2212 by 1659 pixels
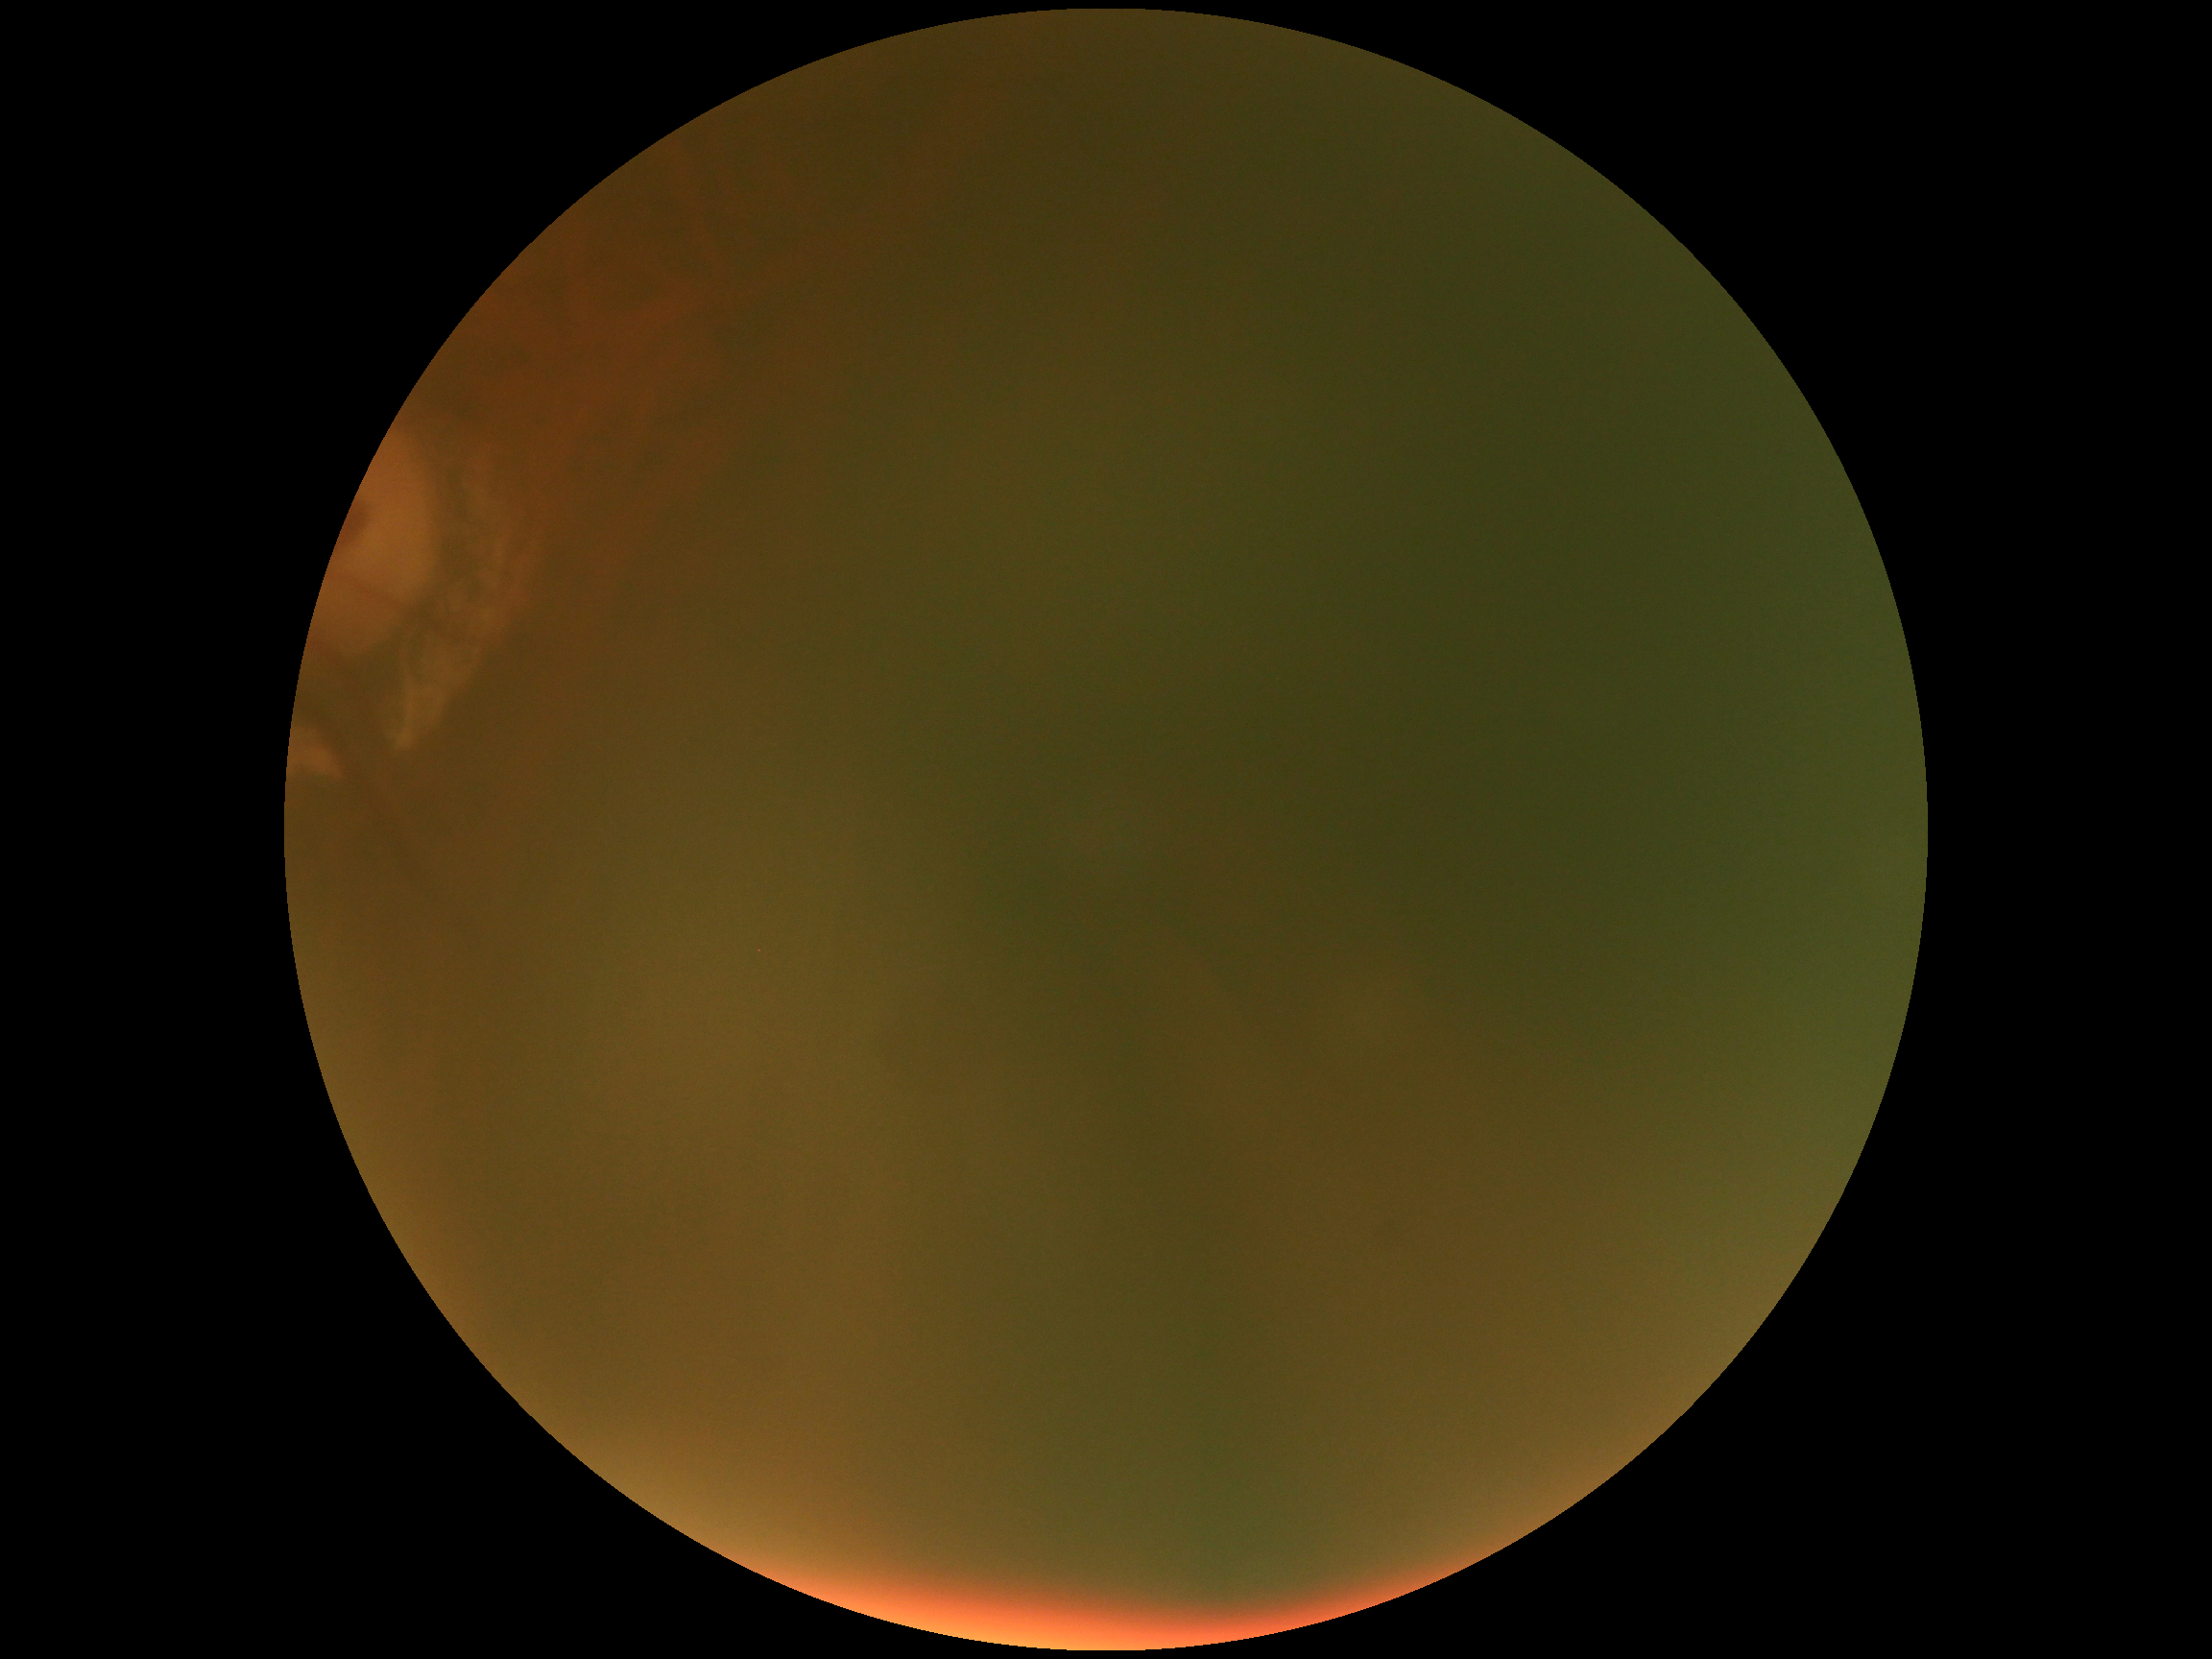

retinopathy grade: ungradable due to poor image quality
image quality: too poor for DR grading